Non-mydriatic fundus camera: 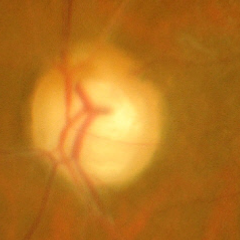

Glaucomatous optic neuropathy is present. Glaucoma stage = advanced glaucomatous optic neuropathy.